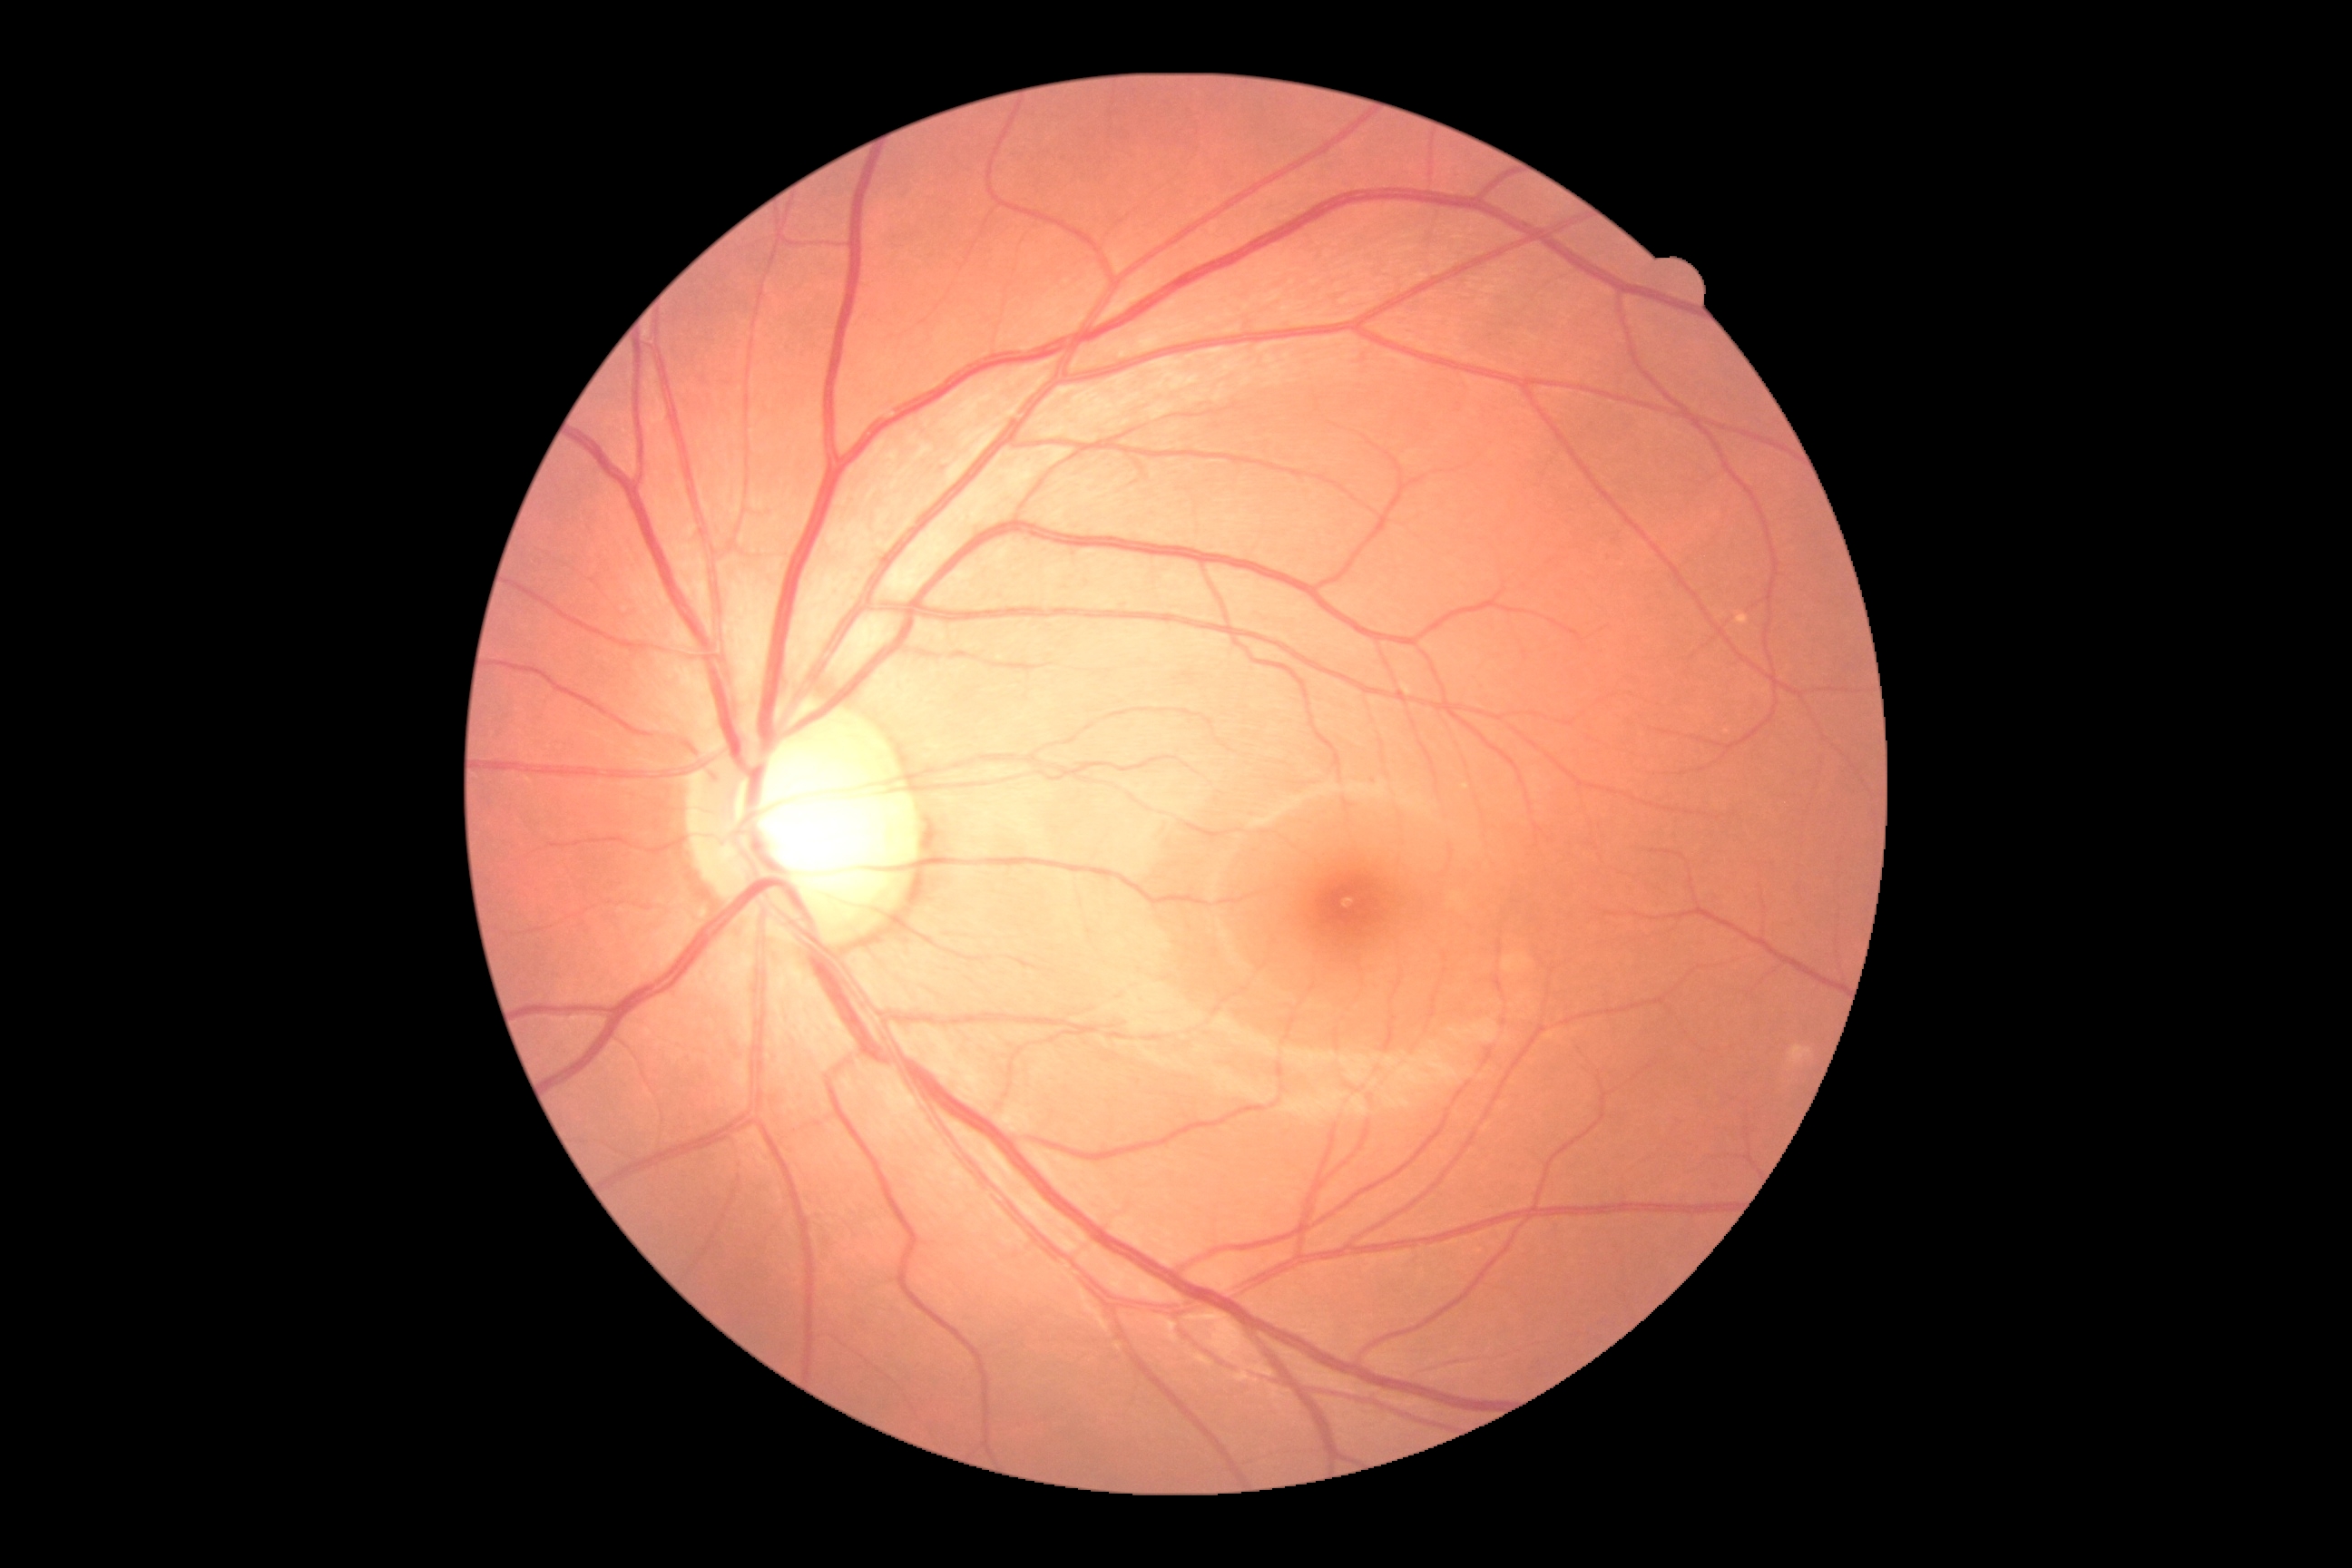 • diabetic retinopathy (DR) — 0/4